CFP:
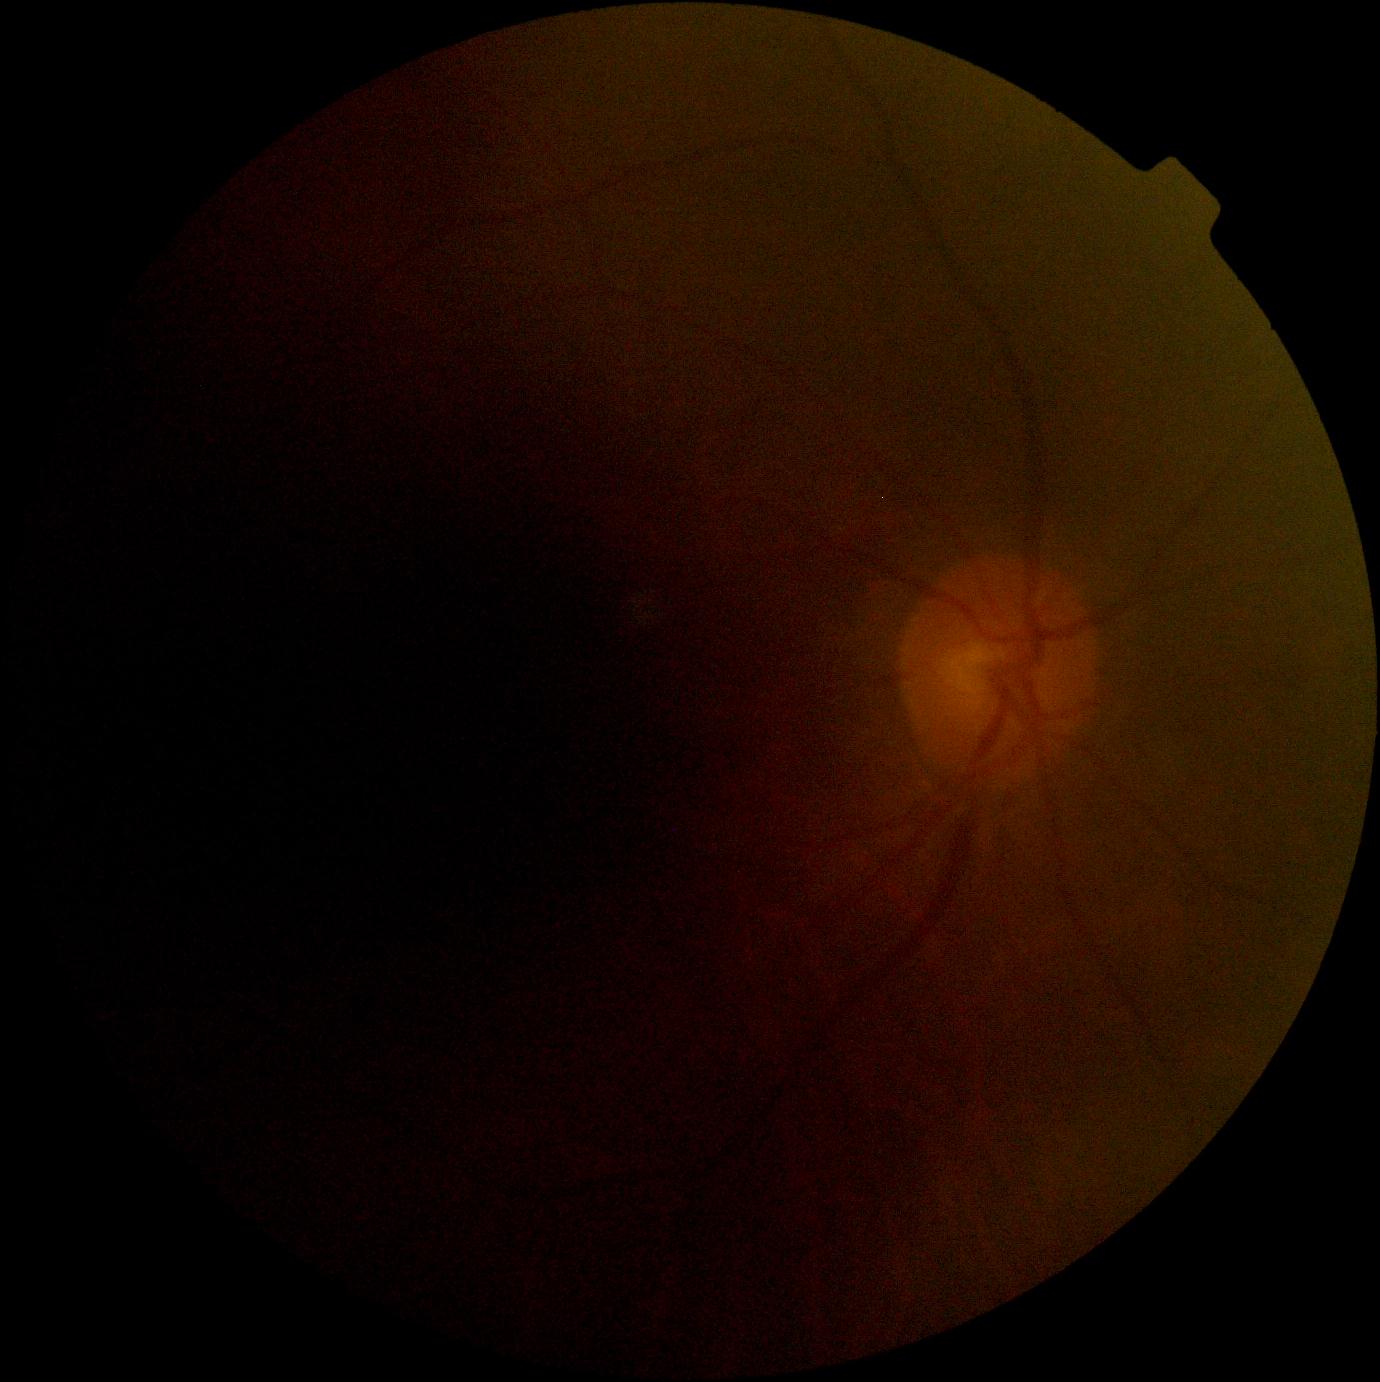
DR severity: ungradable due to poor image quality; image quality: insufficient.